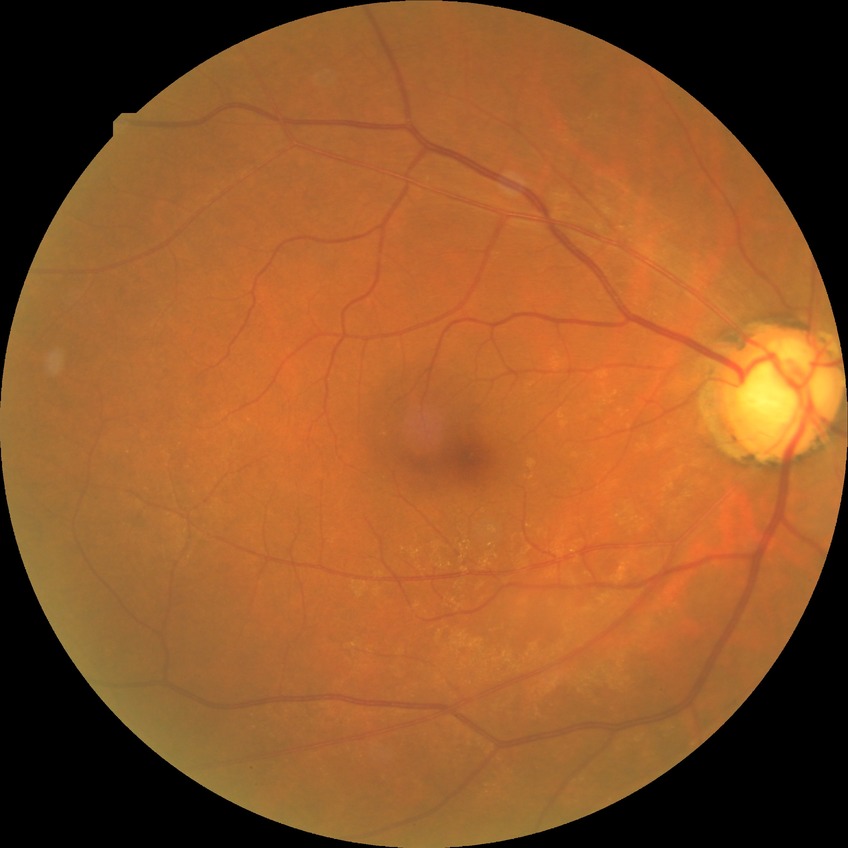 diabetic retinopathy (DR): SDR (simple diabetic retinopathy).